Modified Davis grading. Camera: NIDEK AFC-230. 848x848px: 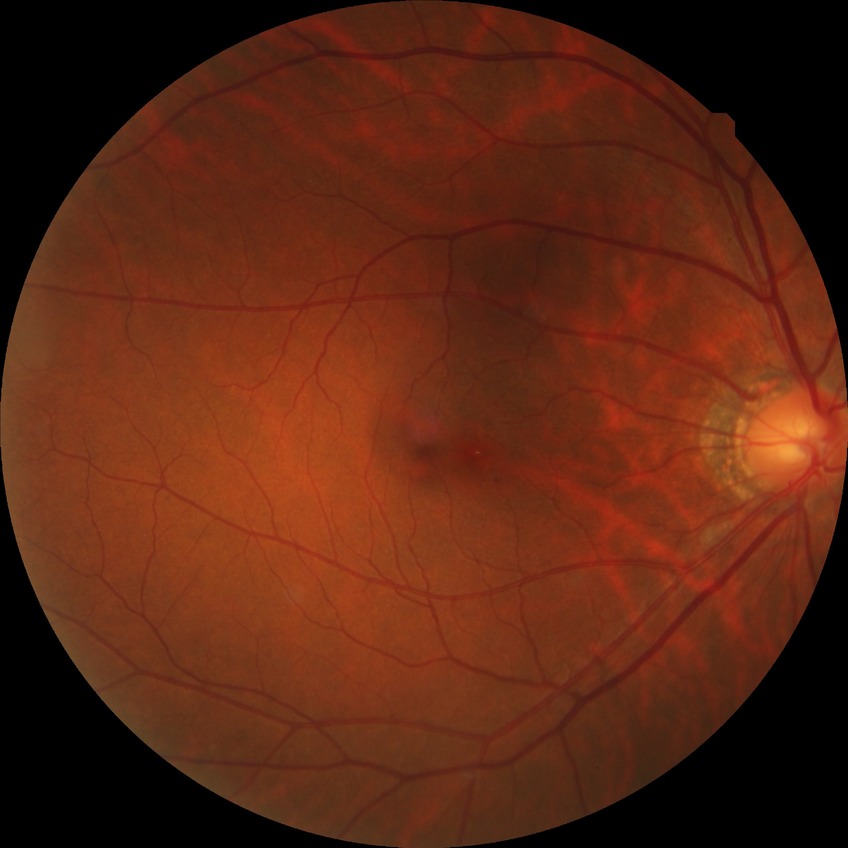 {
  "davis_grade": "NDR (no diabetic retinopathy)"
}